2212x1659px, portable fundus camera image.
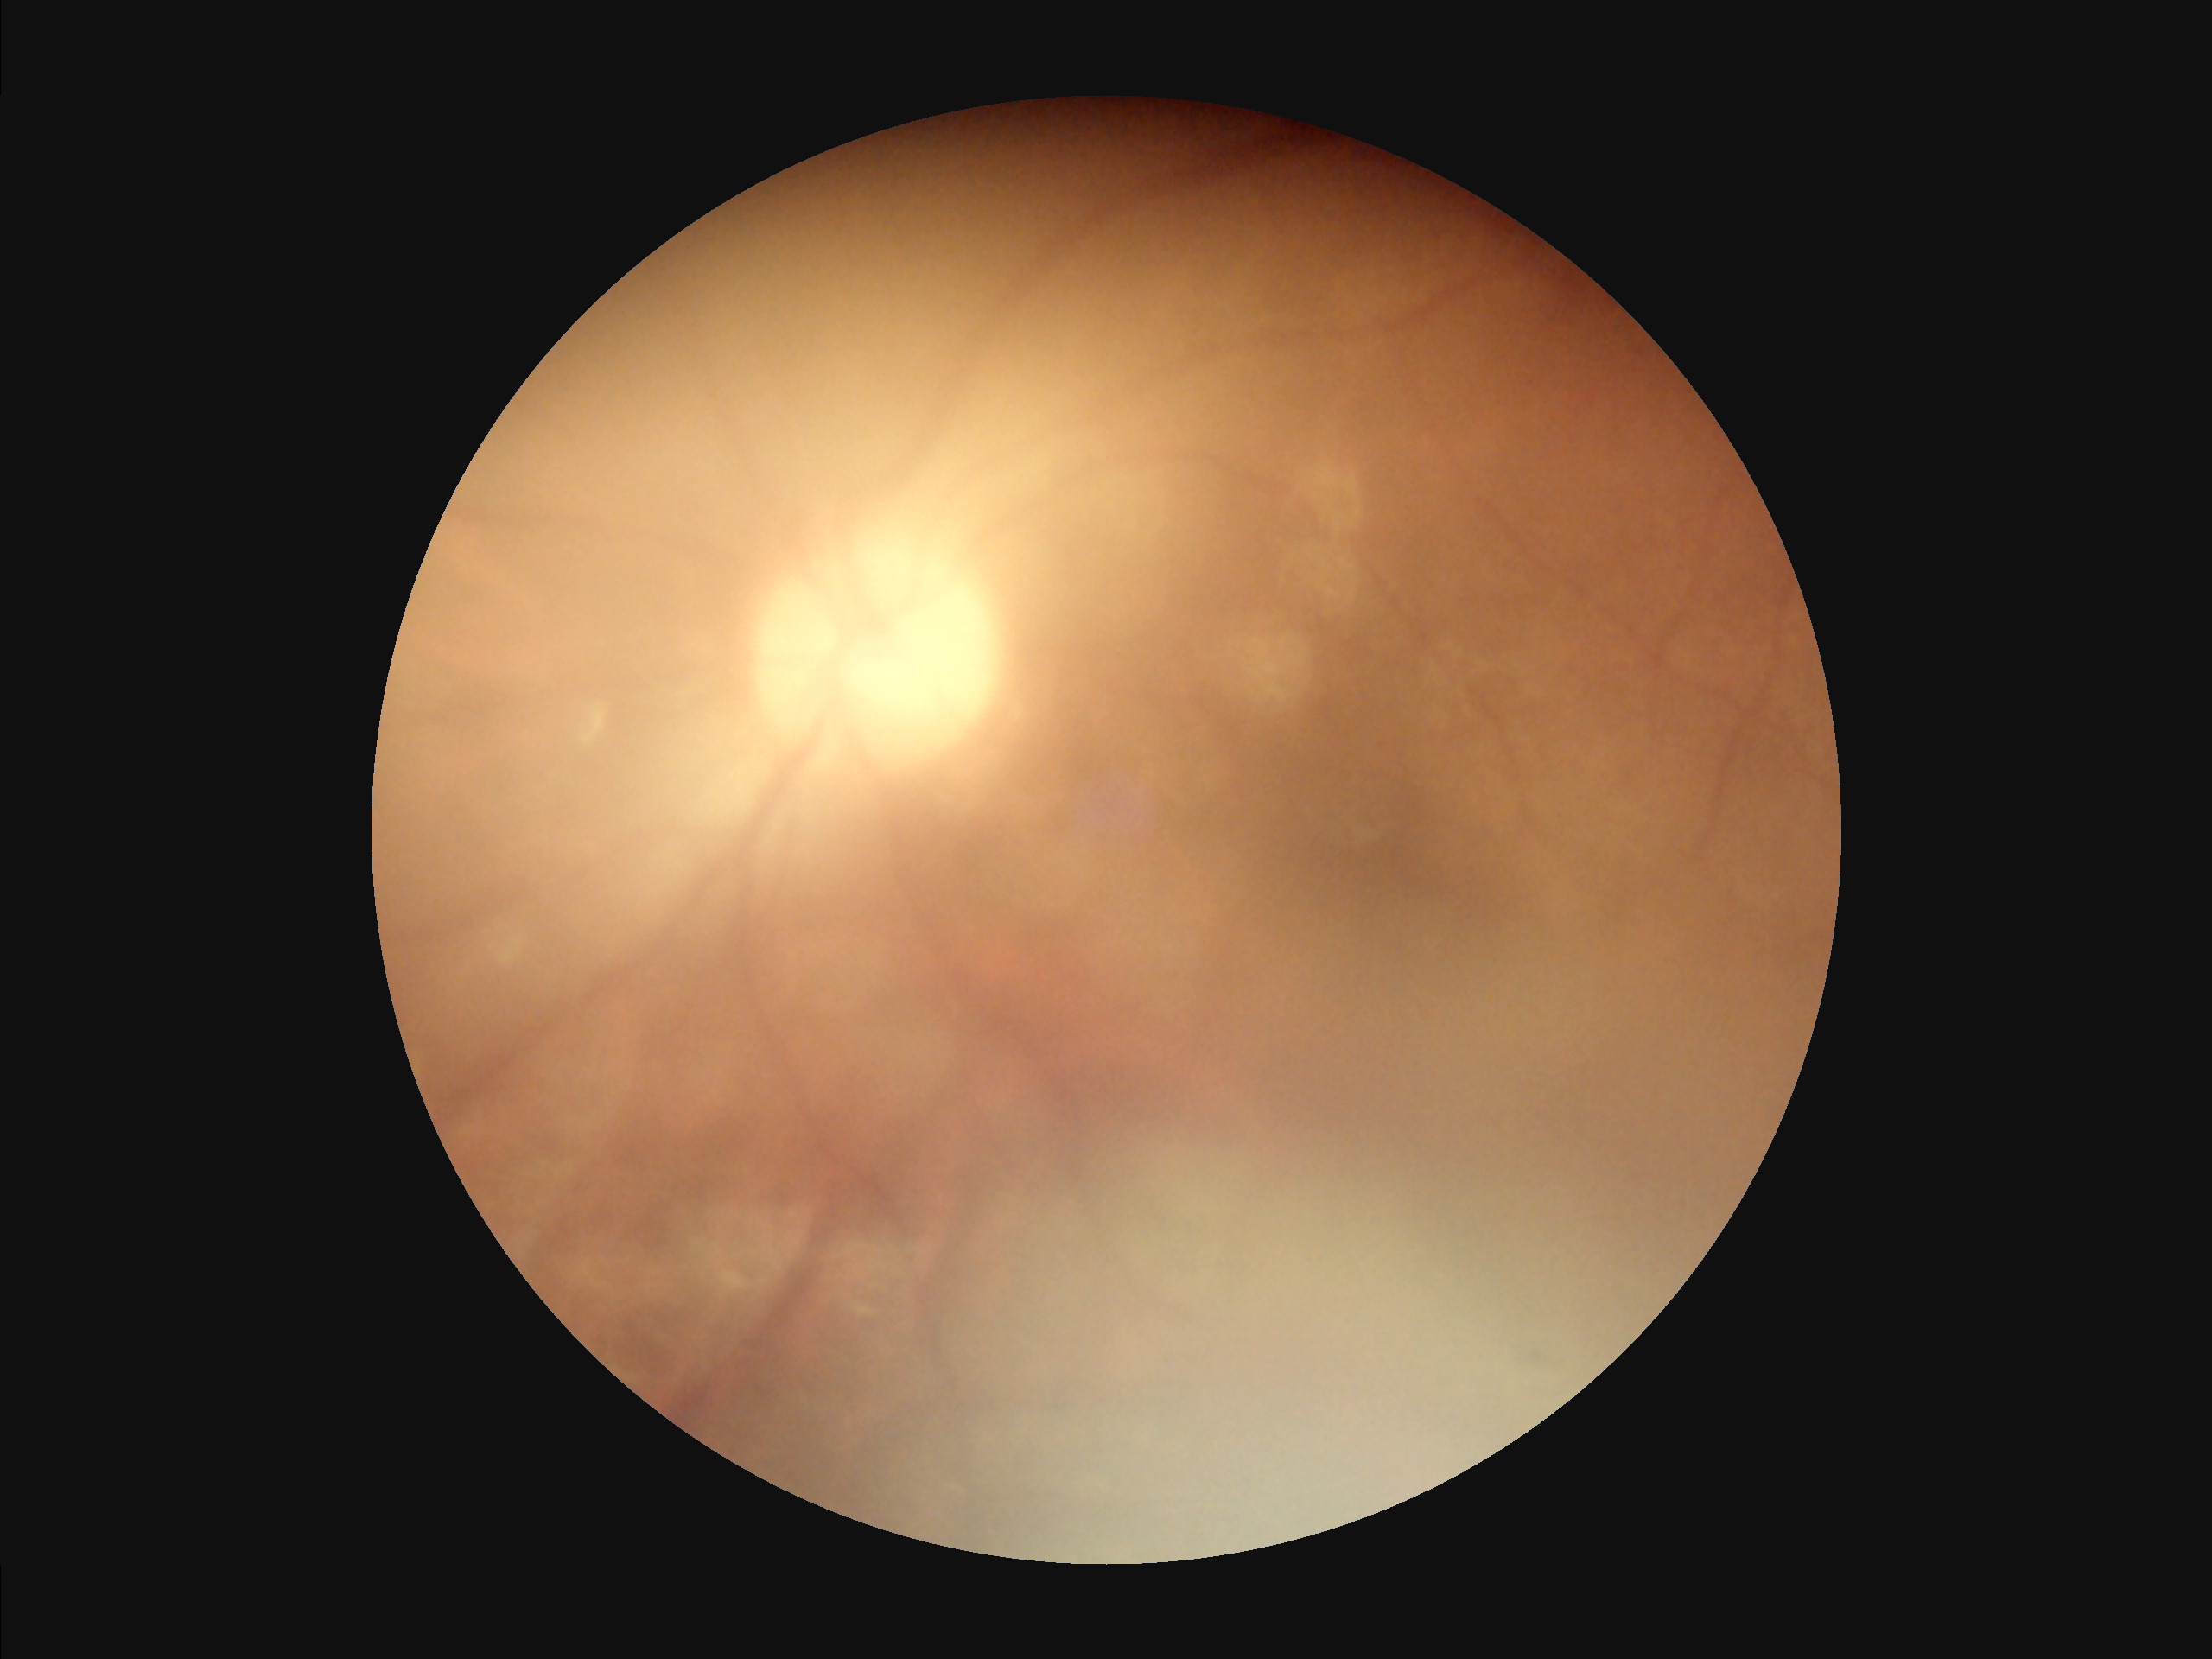

Poor dynamic range. Image quality is inadequate for diagnostic use. Illumination is even. Noticeable blur in the optic disc, vessels, or background.